Non-mydriatic acquisition
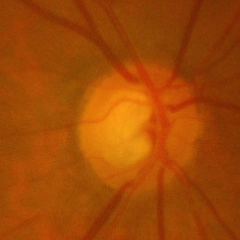 Glaucoma stage: early glaucomatous changes.